RetCam wide-field infant fundus image. 1440 x 1080 pixels:
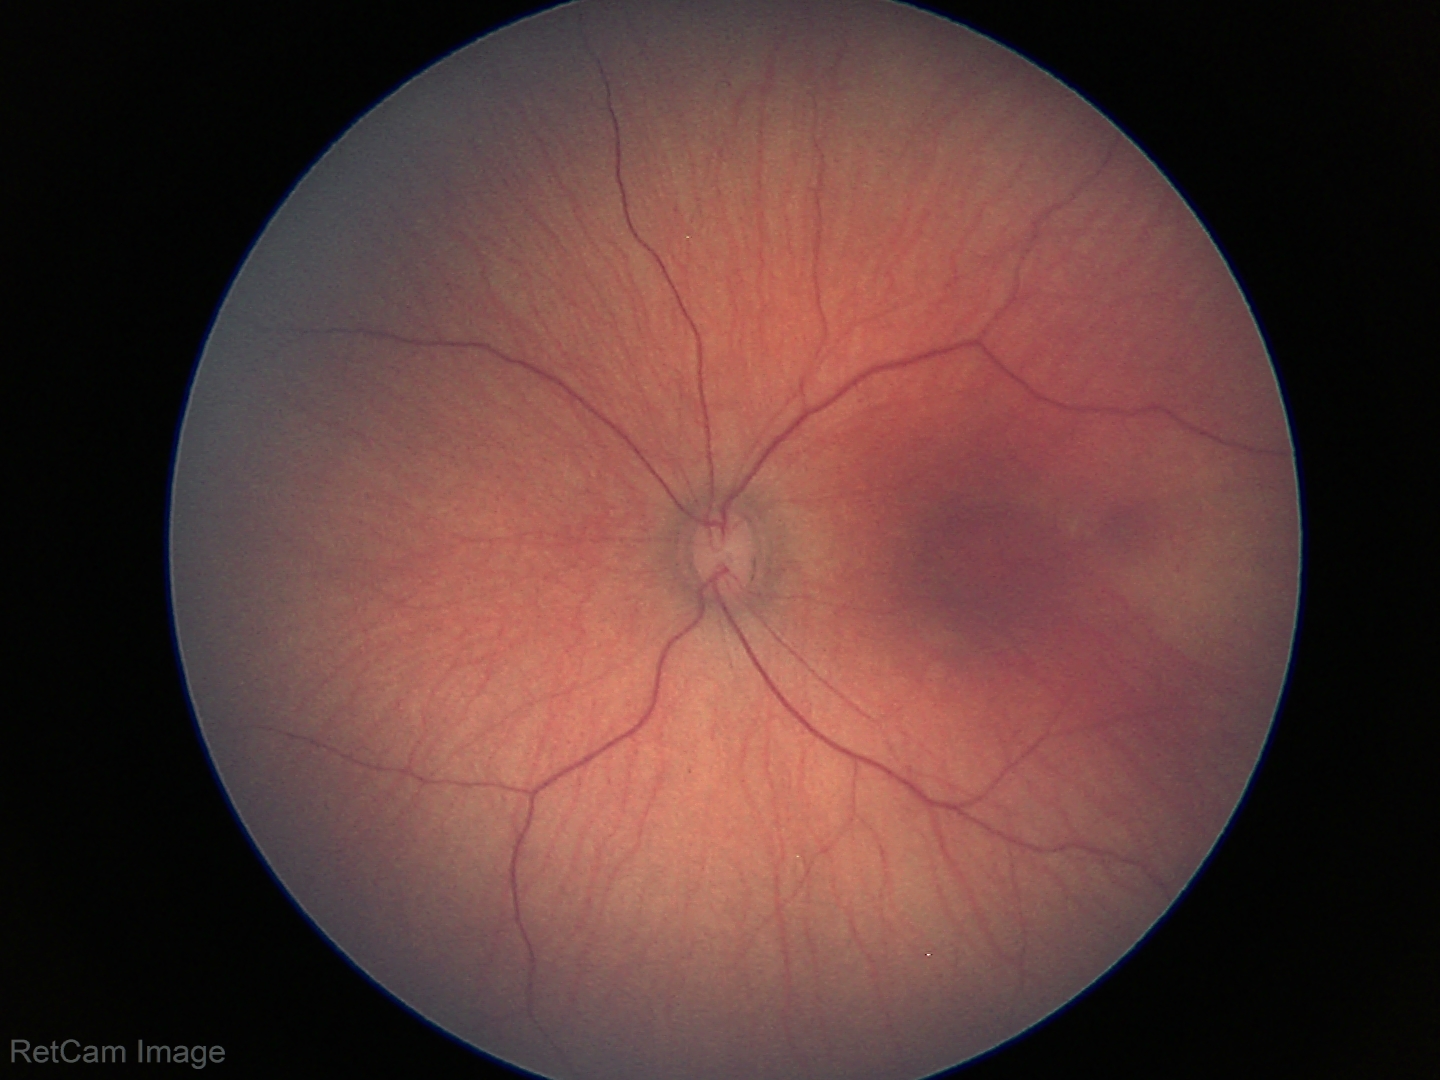 Screening examination with no abnormal retinal findings.